848 x 848 pixels:
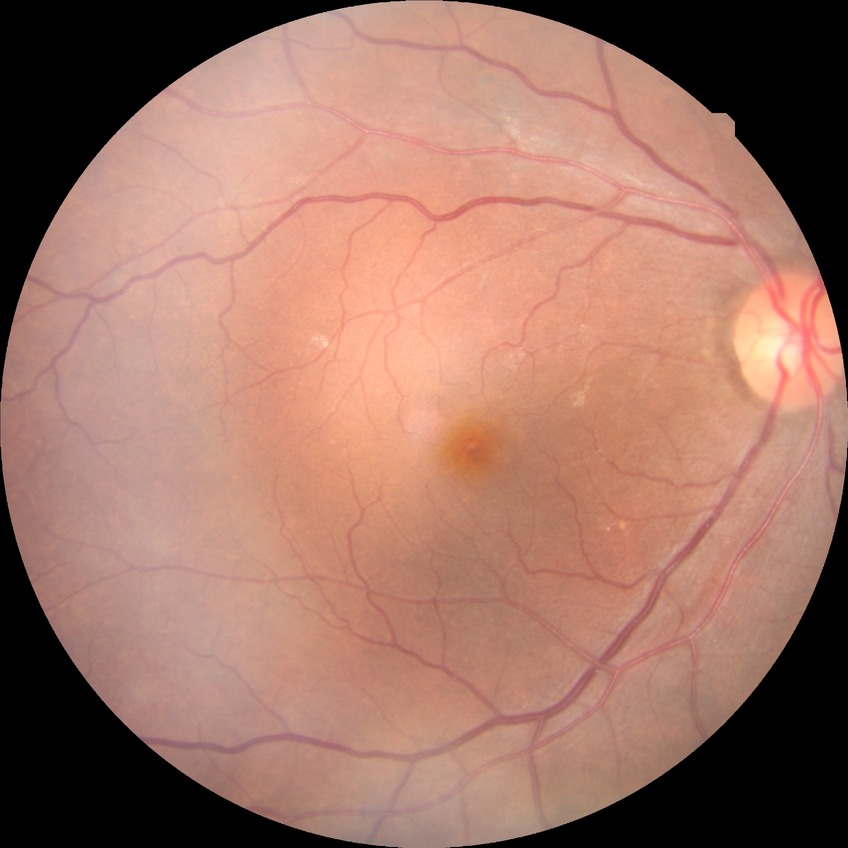

– diabetic retinopathy (DR): no diabetic retinopathy (NDR)